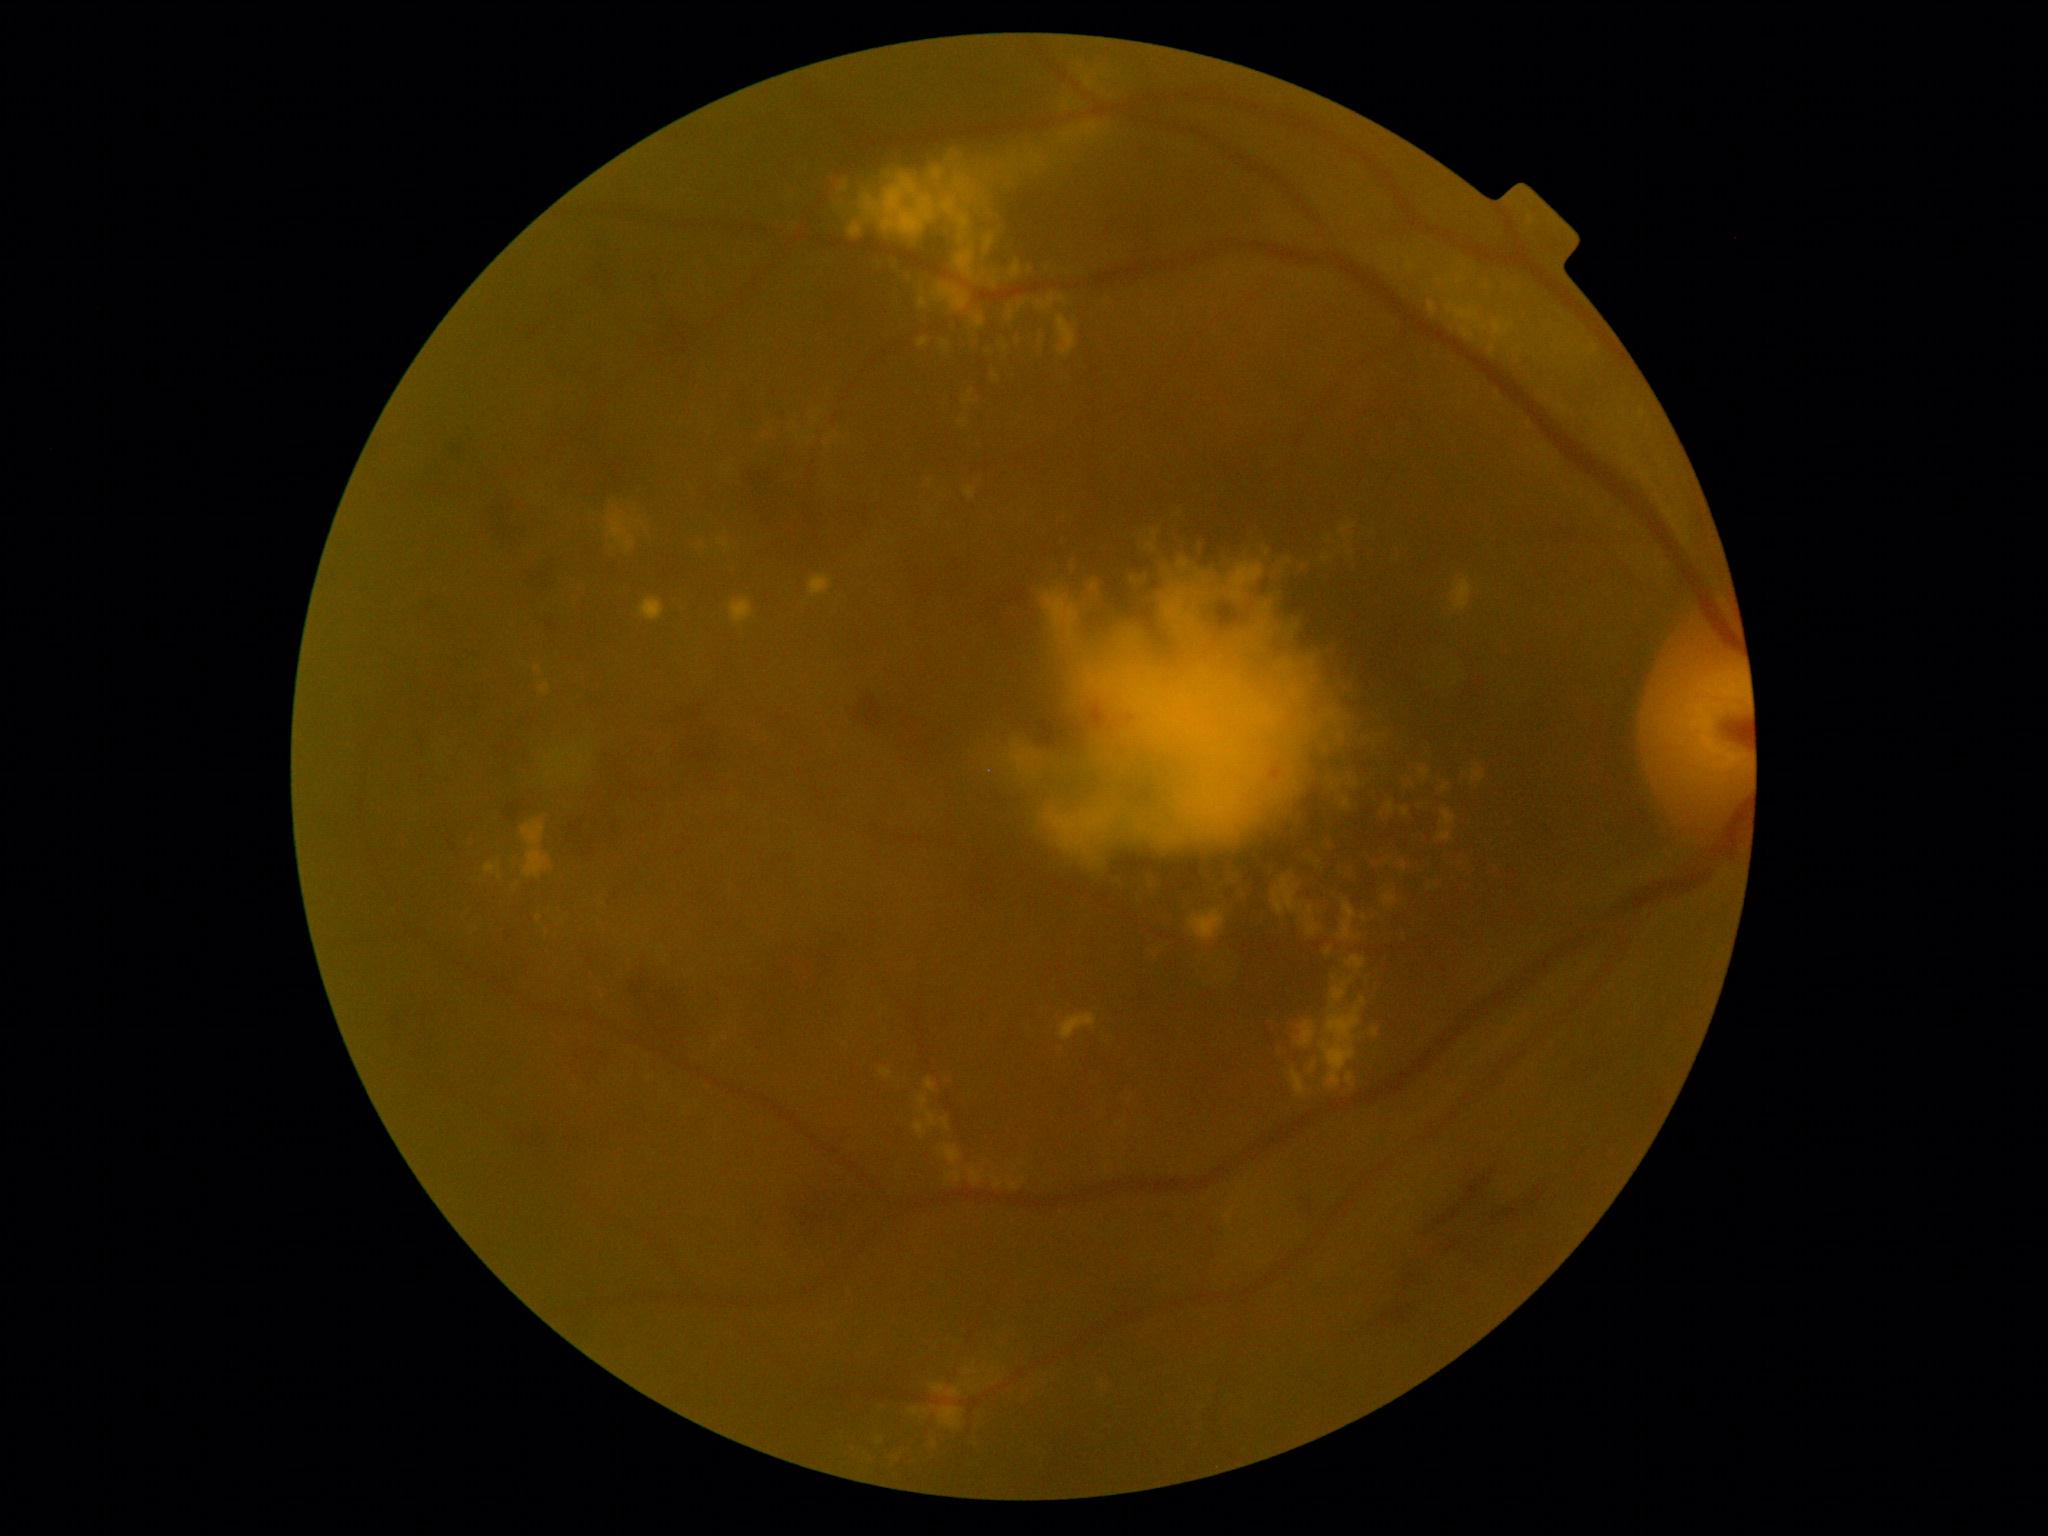

DR stage: grade 2 (moderate NPDR) — more than just microaneurysms but less than severe NPDR.
EXs include rect(842, 181, 849, 192) | rect(1061, 132, 1074, 145) | rect(608, 510, 635, 553) | rect(1291, 558, 1311, 574) | rect(1439, 832, 1452, 843) | rect(878, 1437, 883, 1445) | rect(962, 1336, 1054, 1447) | rect(919, 1094, 938, 1130) | rect(1298, 1021, 1315, 1047) | rect(1201, 863, 1216, 880) | rect(1387, 801, 1396, 814) | rect(944, 175, 980, 212) | rect(1288, 1008, 1301, 1035) | rect(1057, 315, 1077, 357) | rect(960, 419, 968, 426) | rect(1071, 555, 1080, 578) | rect(945, 148, 967, 174).
Small EXs approximately at pt(1365, 918).